Color fundus photograph: 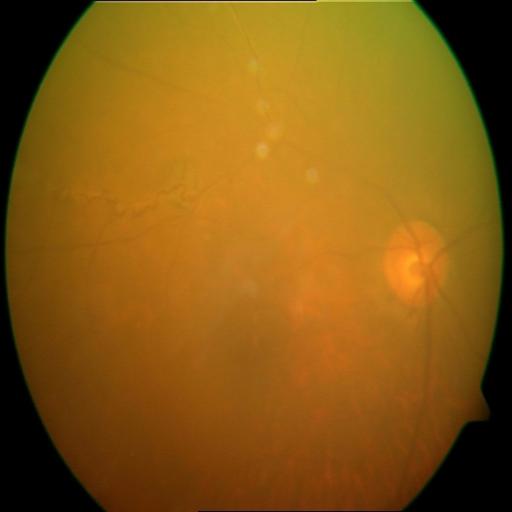 There is evidence of laser scars (LS) and collateral vessels (CL).